Image size 848x848; CFP; camera: NIDEK AFC-230
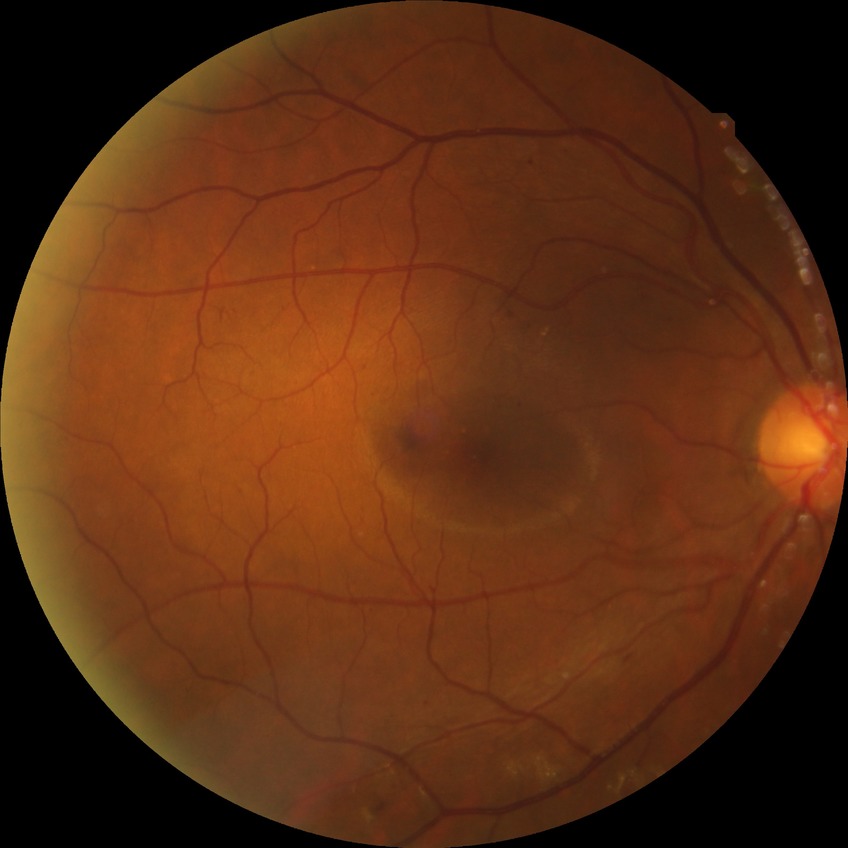
  davis_grade: simple diabetic retinopathy (SDR)